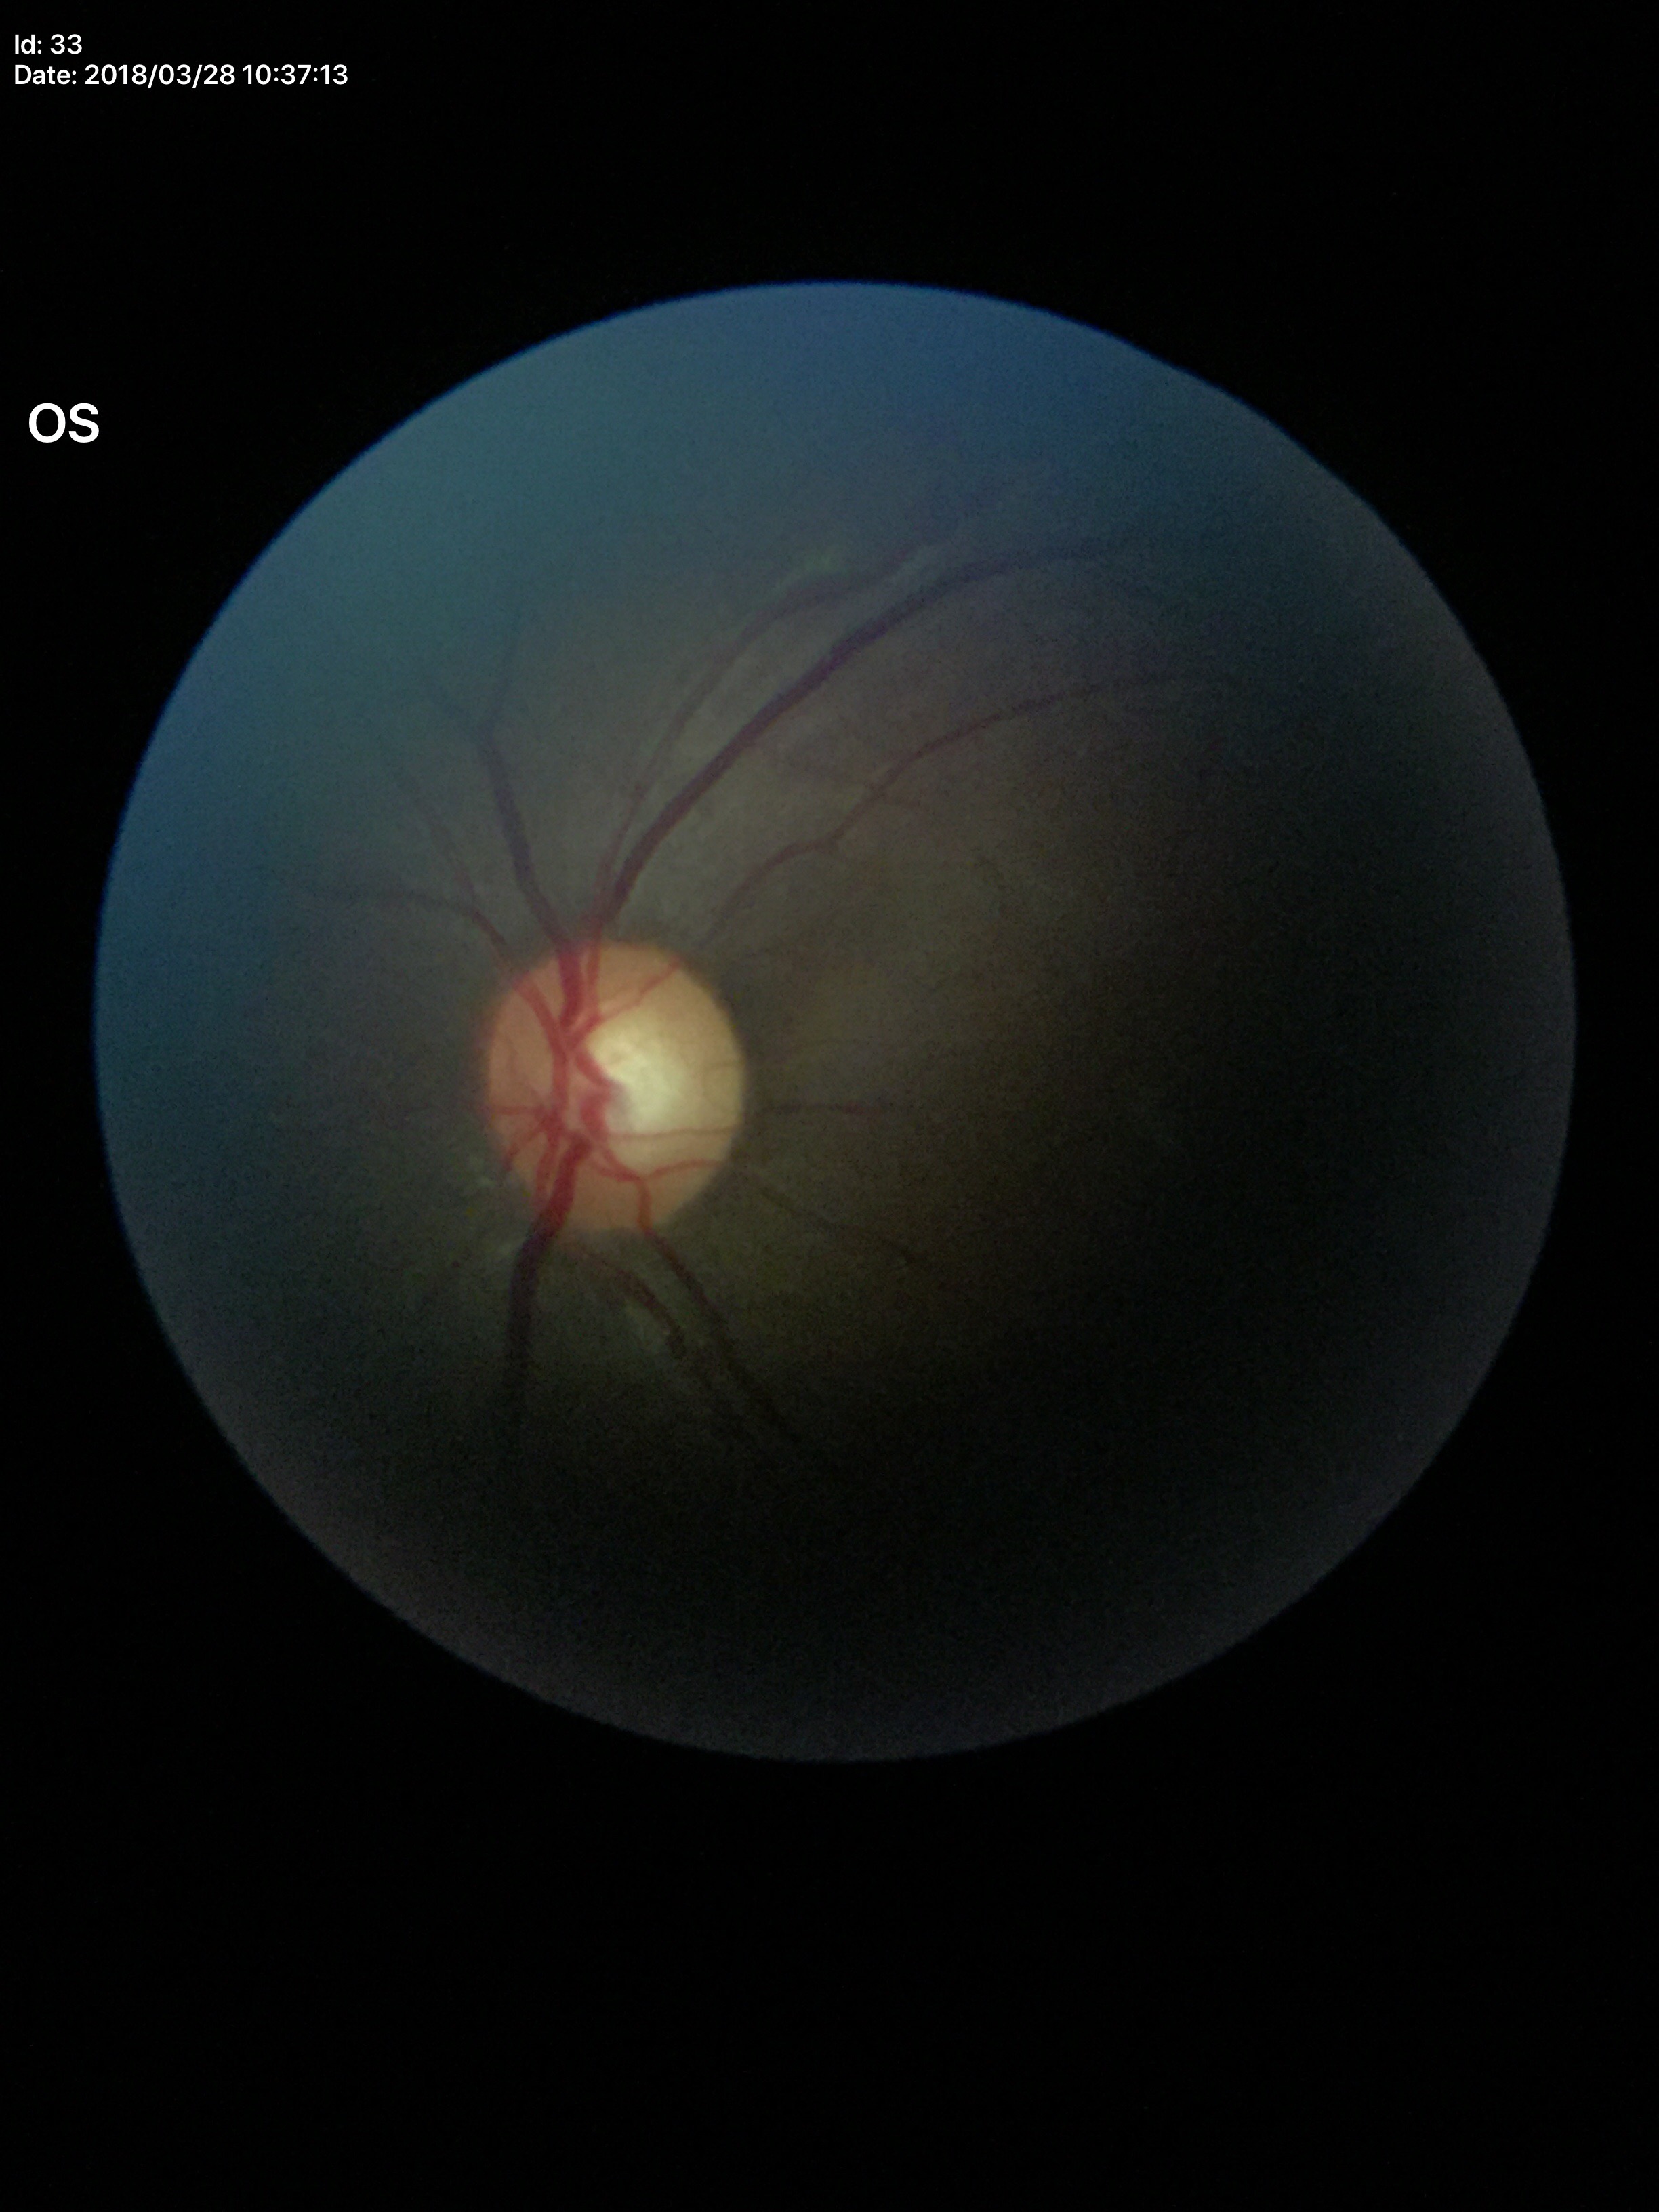 Q: Glaucoma screening result?
A: negative (2 of 5 graders flagged glaucoma suspect)
Q: What is the VCDR?
A: 0.57
Q: What is the HCDR?
A: 0.57